Wide-field contact fundus photograph of an infant; 1240x1240
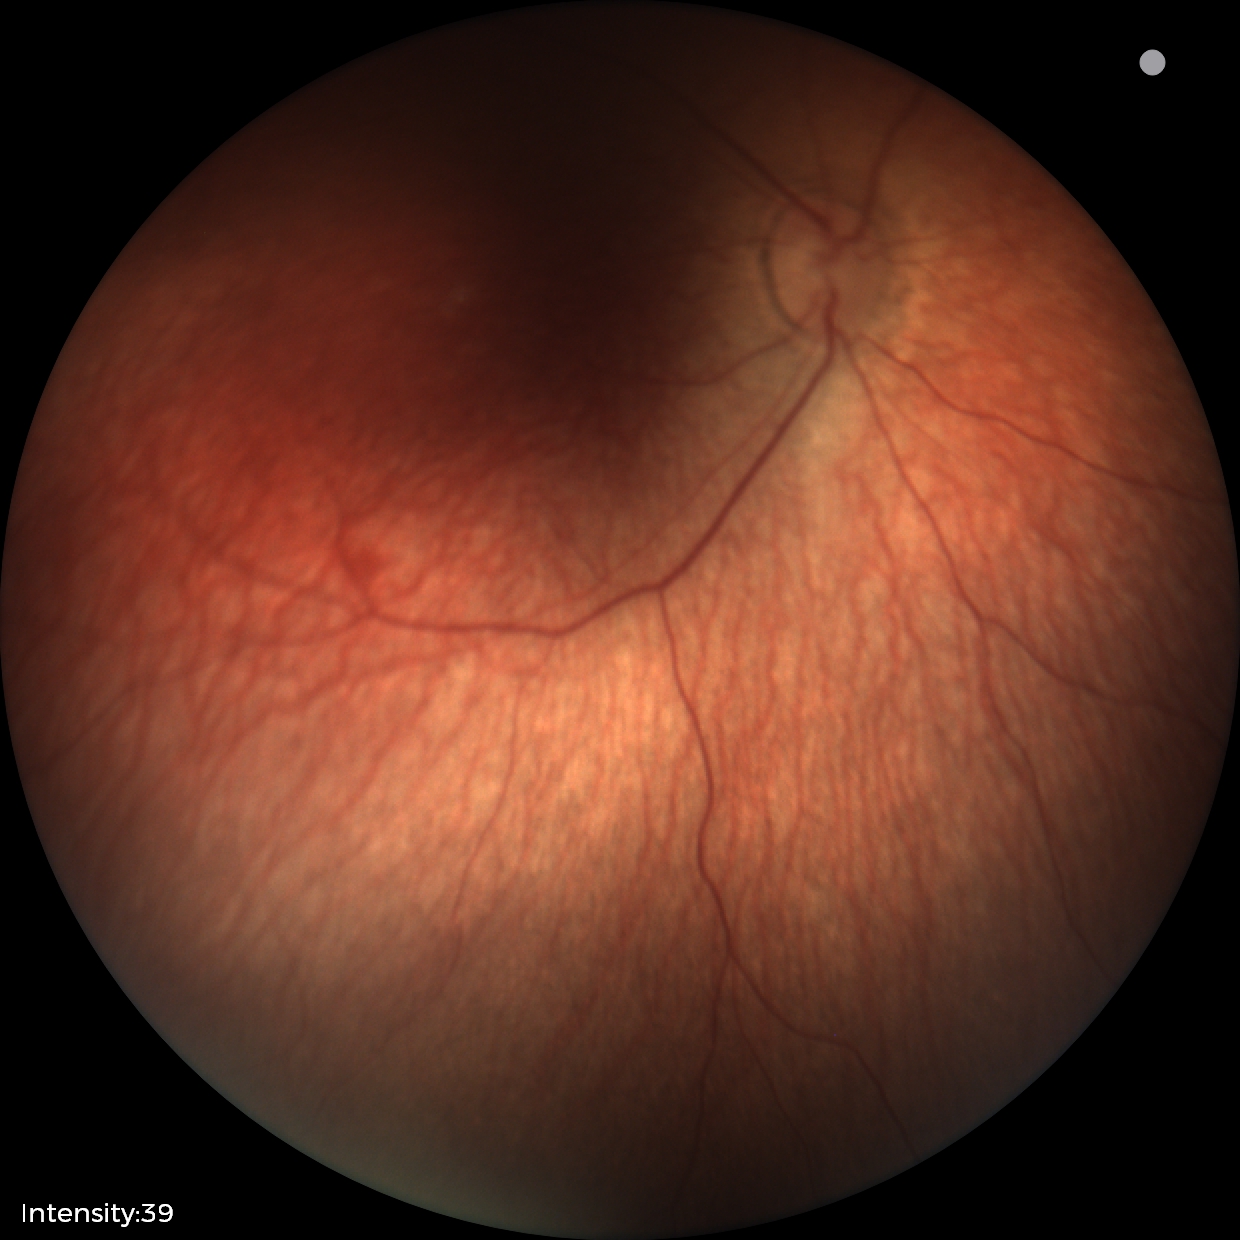 Examination with physiological retinal findings.